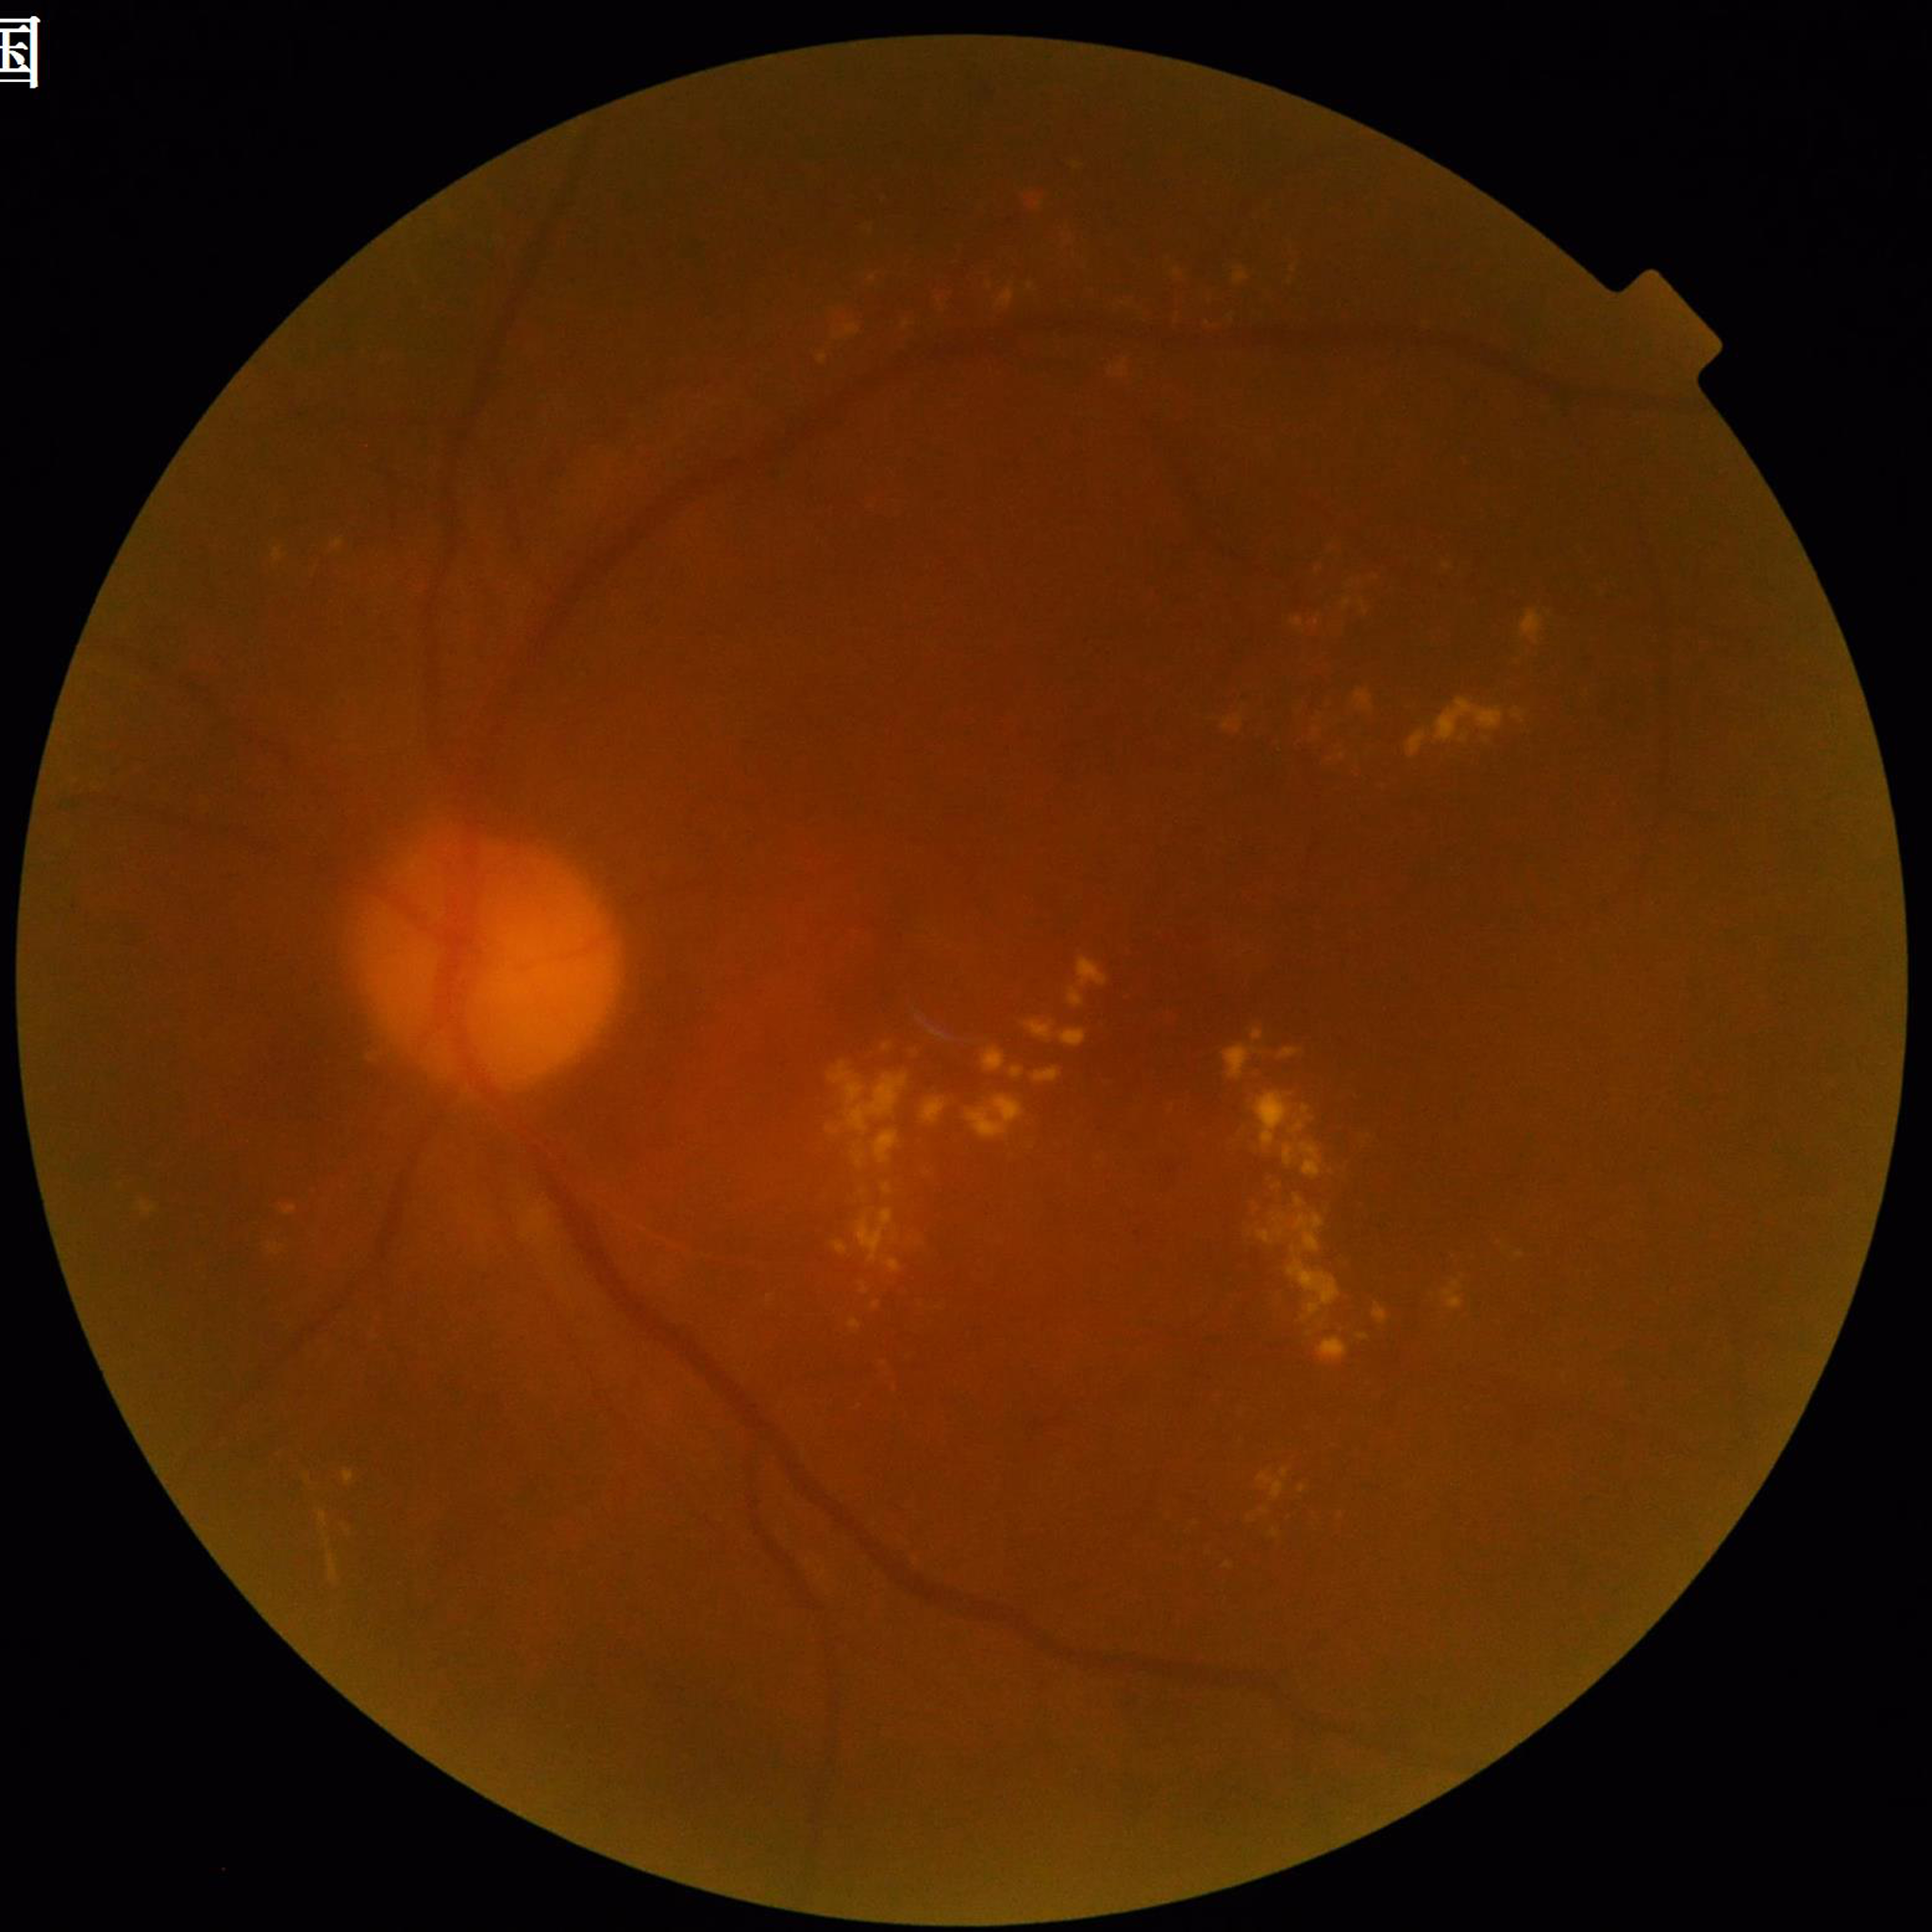 image_quality: issues noted — blur
diagnosis: diabetic retinopathy